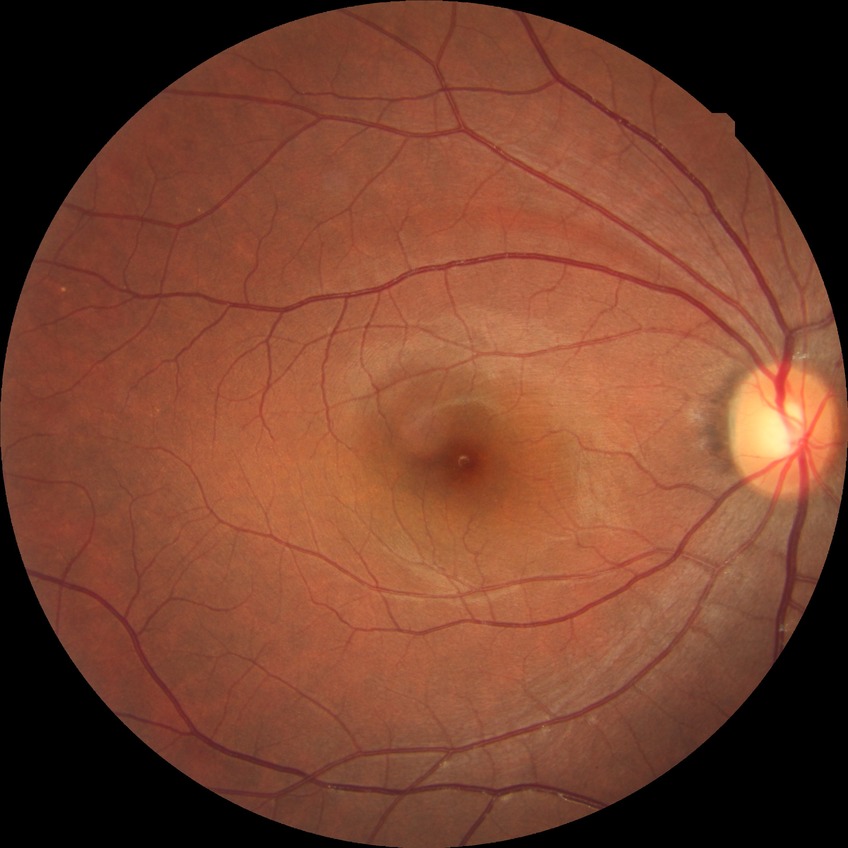
Diabetic retinopathy (DR): no diabetic retinopathy (NDR).